Ultra-widefield fundus mosaic
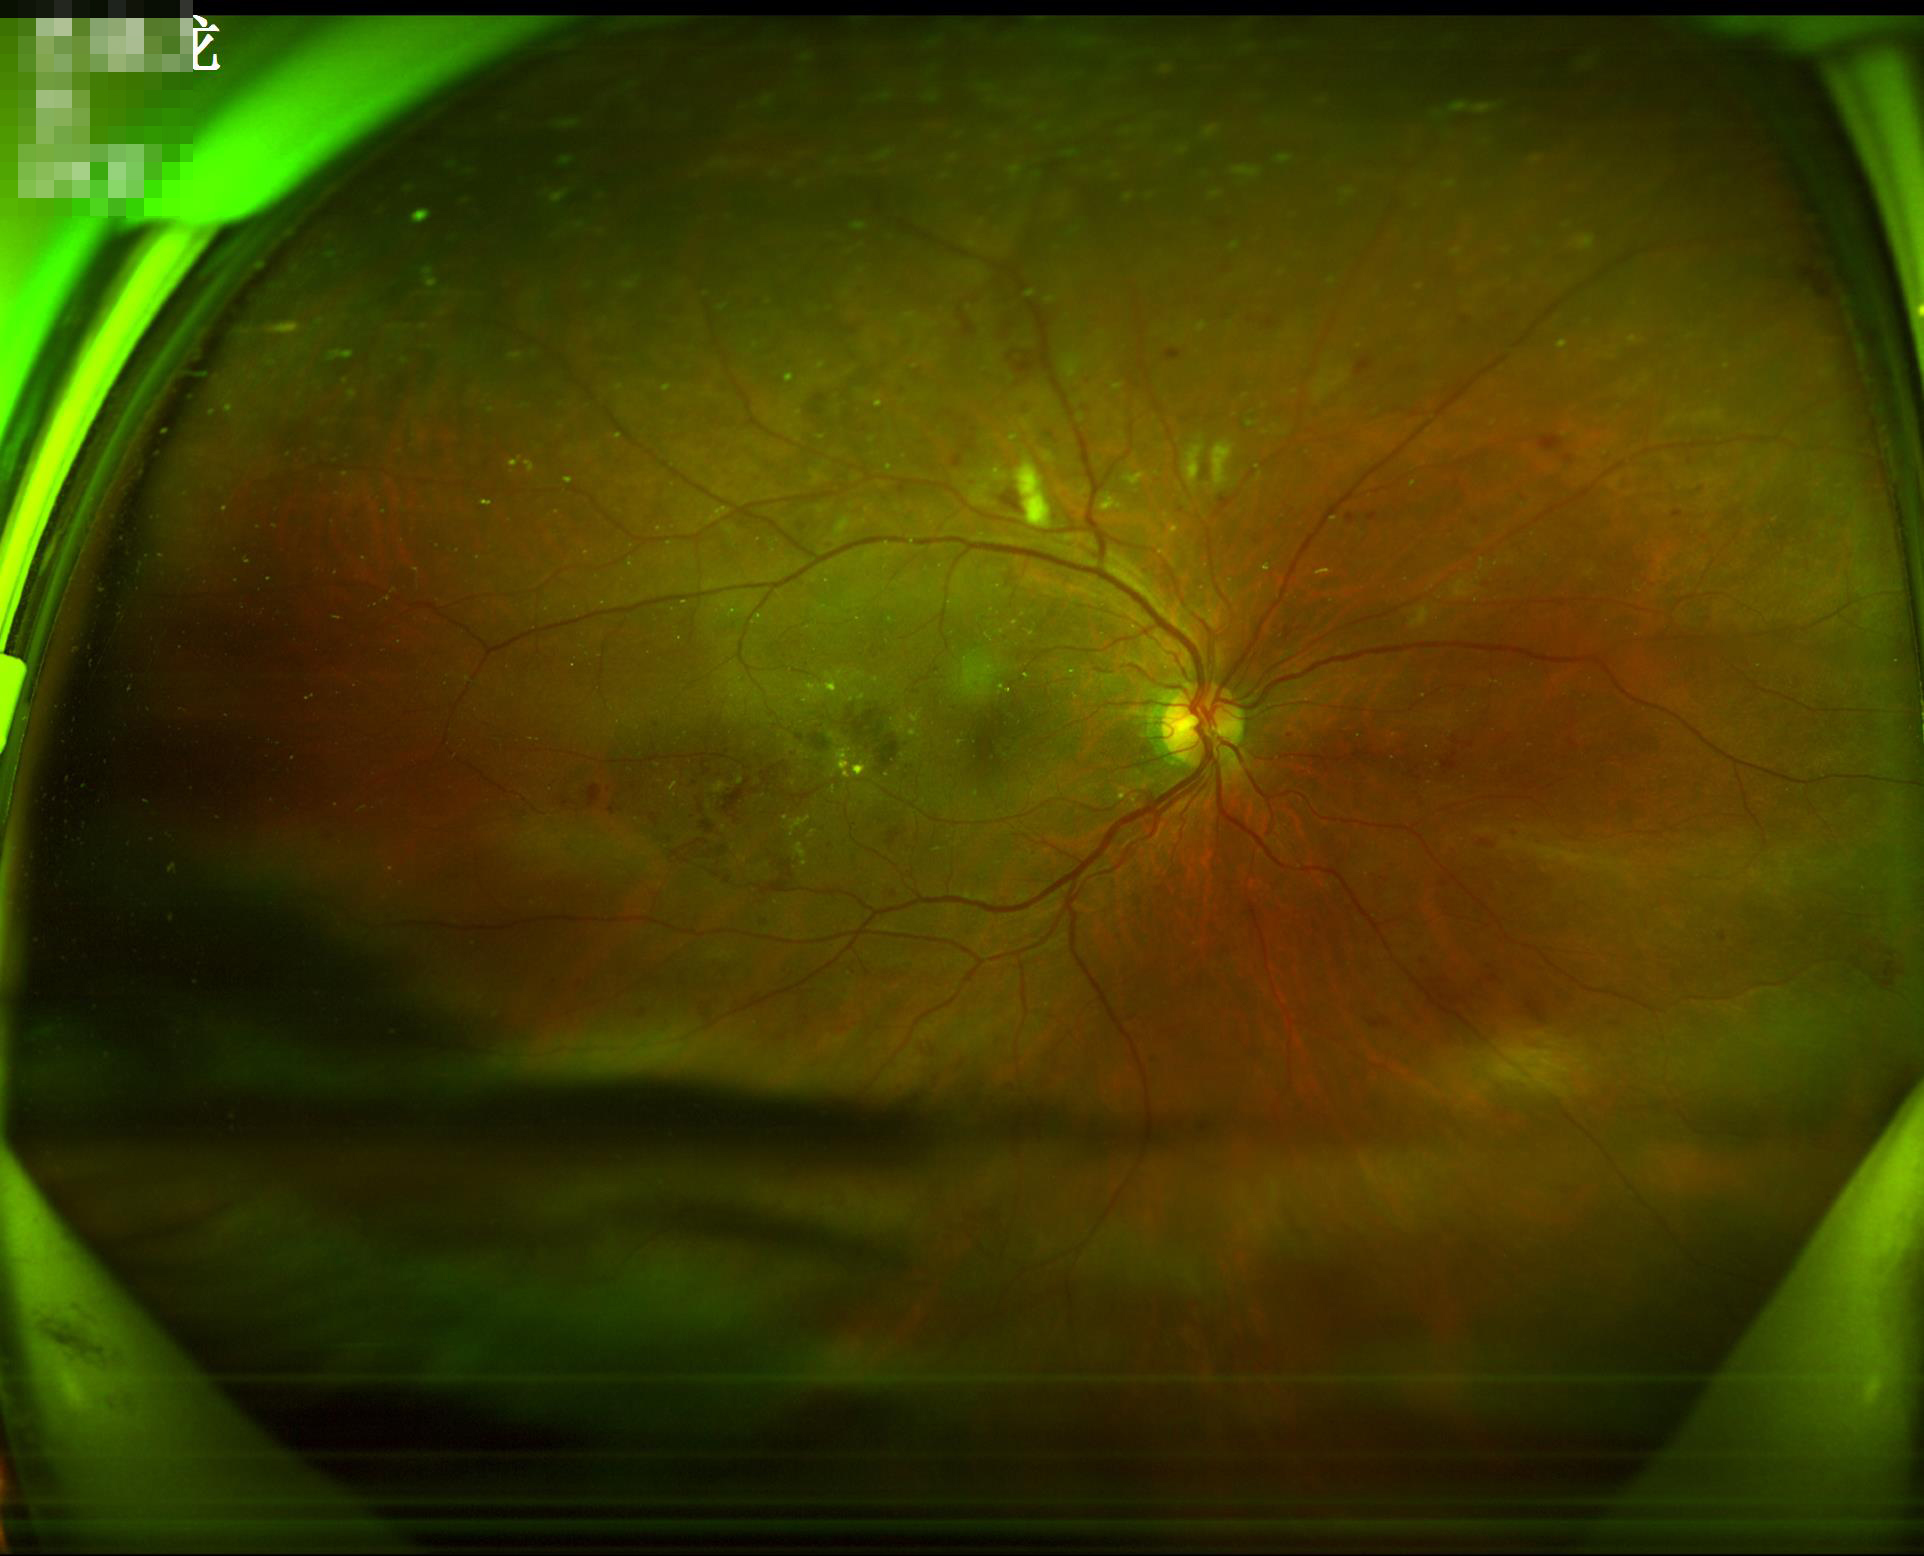 There is over- or under-exposure or a color cast. Acceptable image quality.